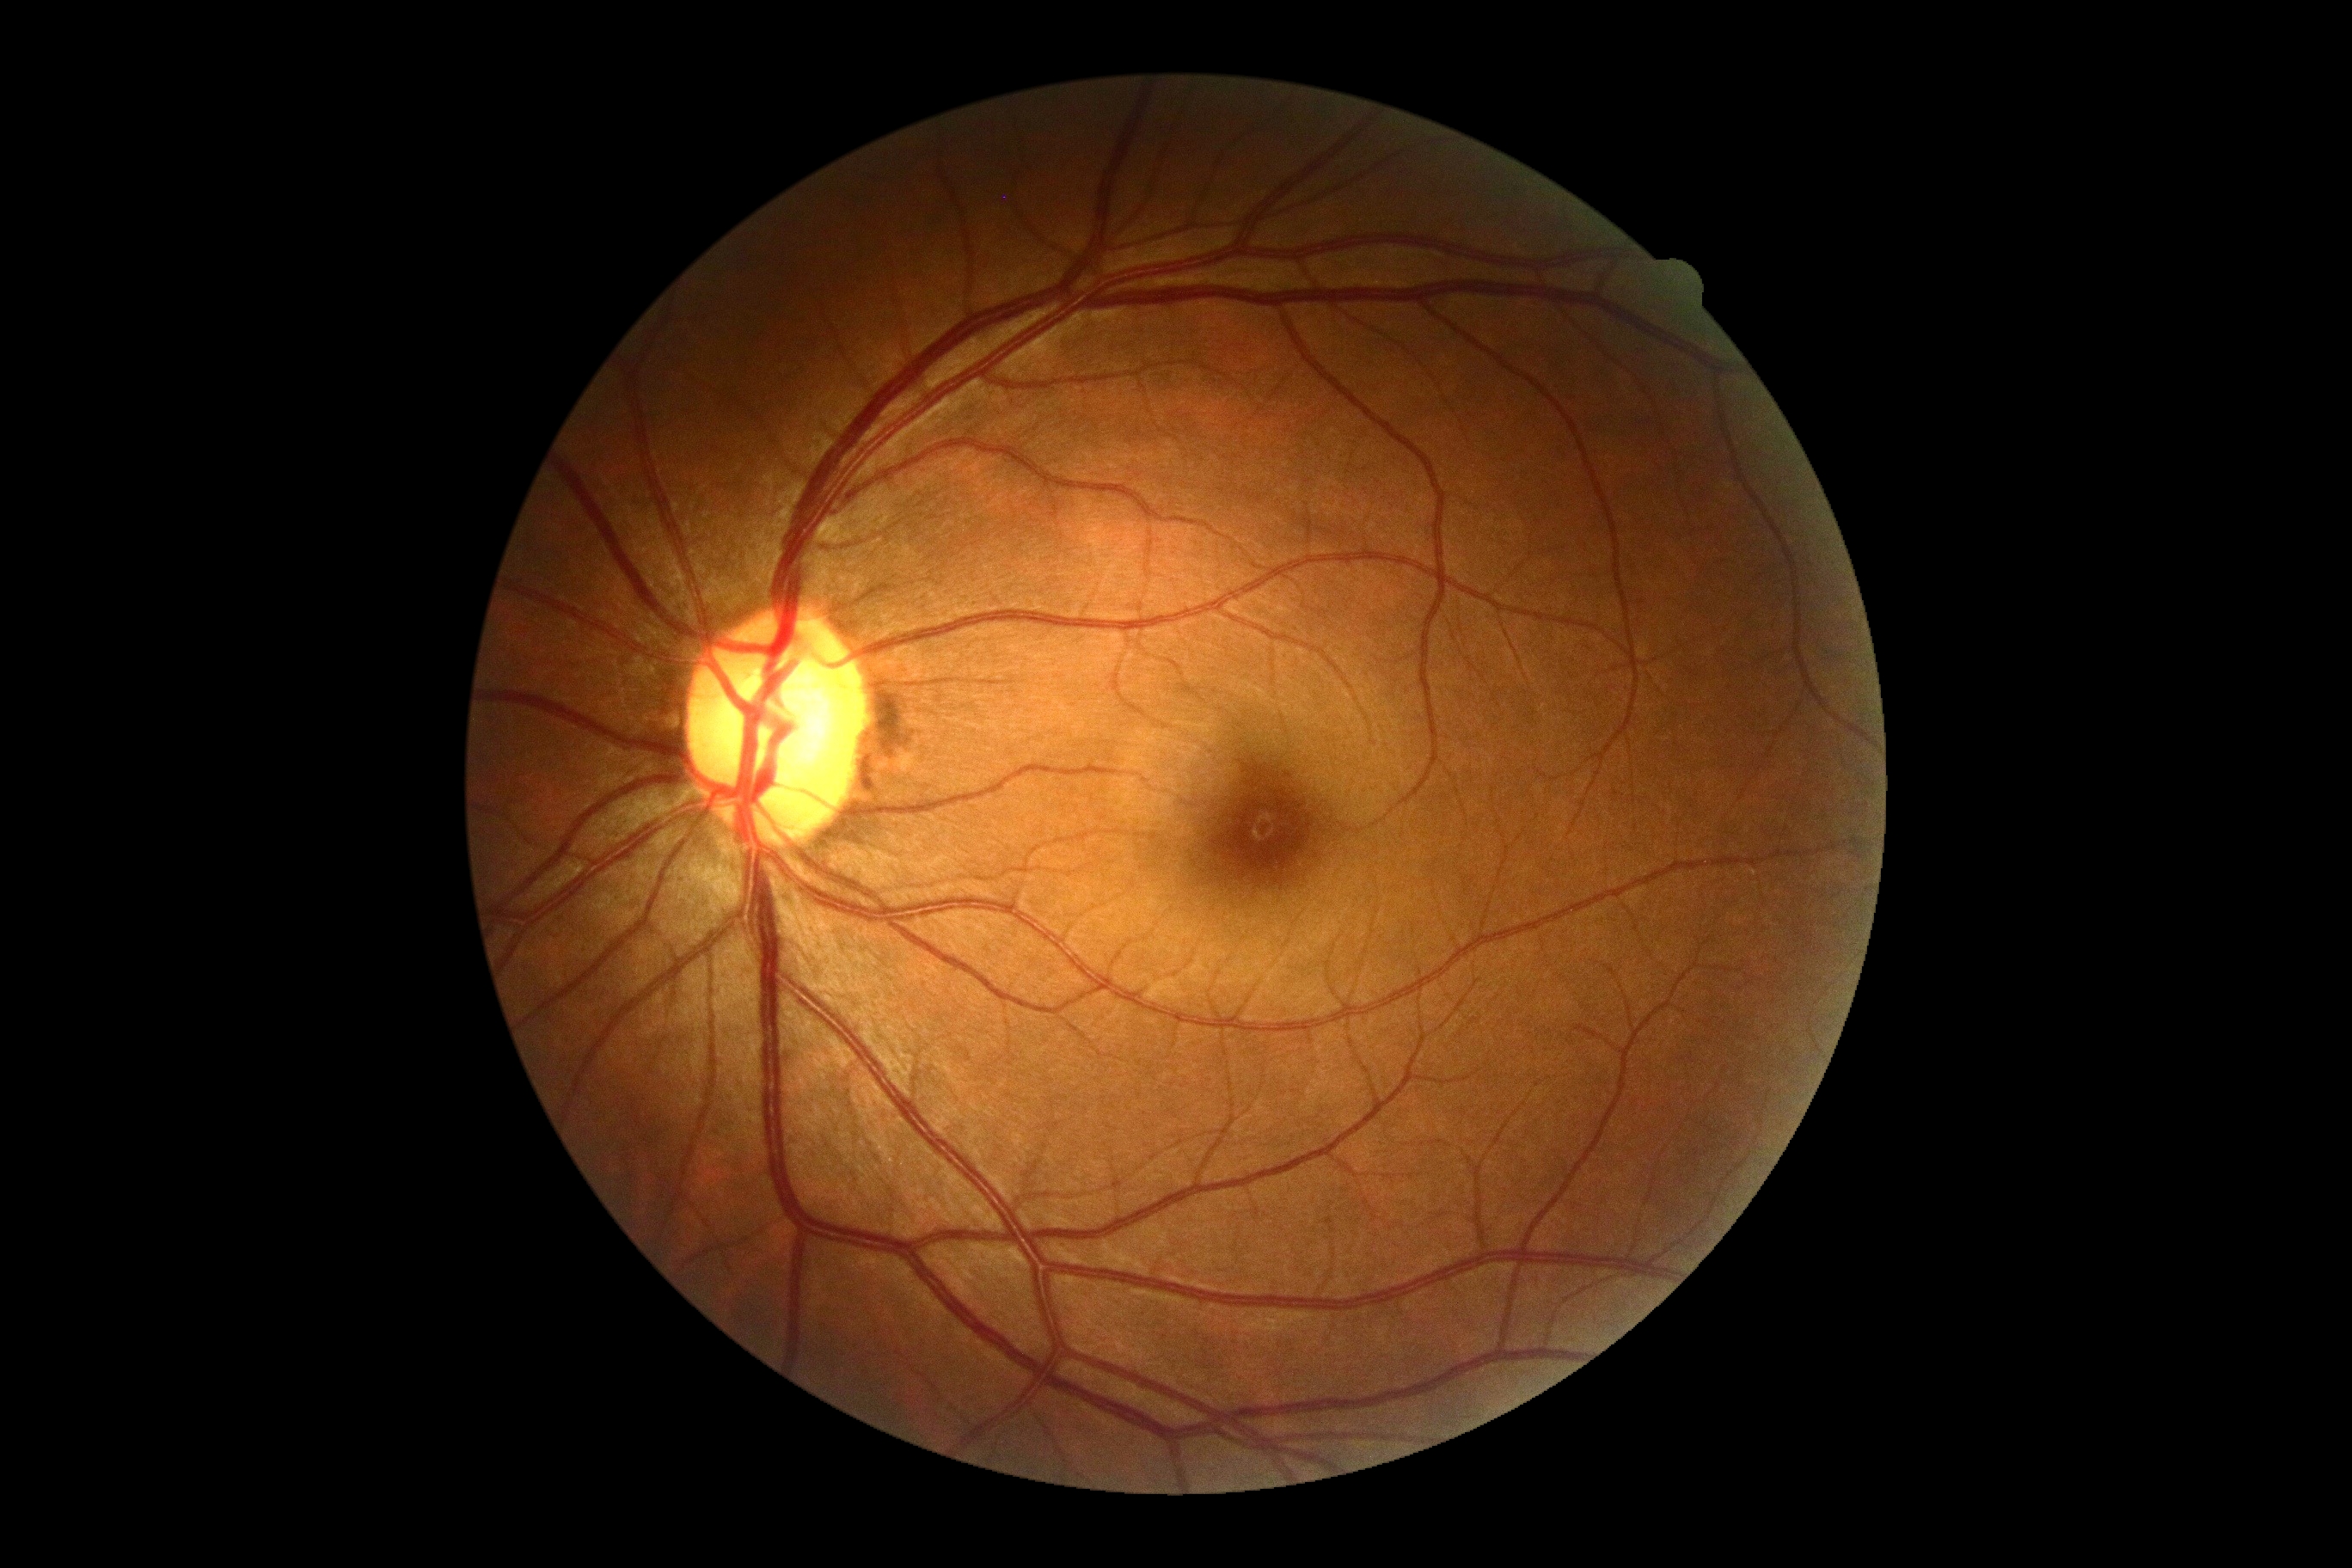

Diabetic retinopathy (DR) is 0/4.